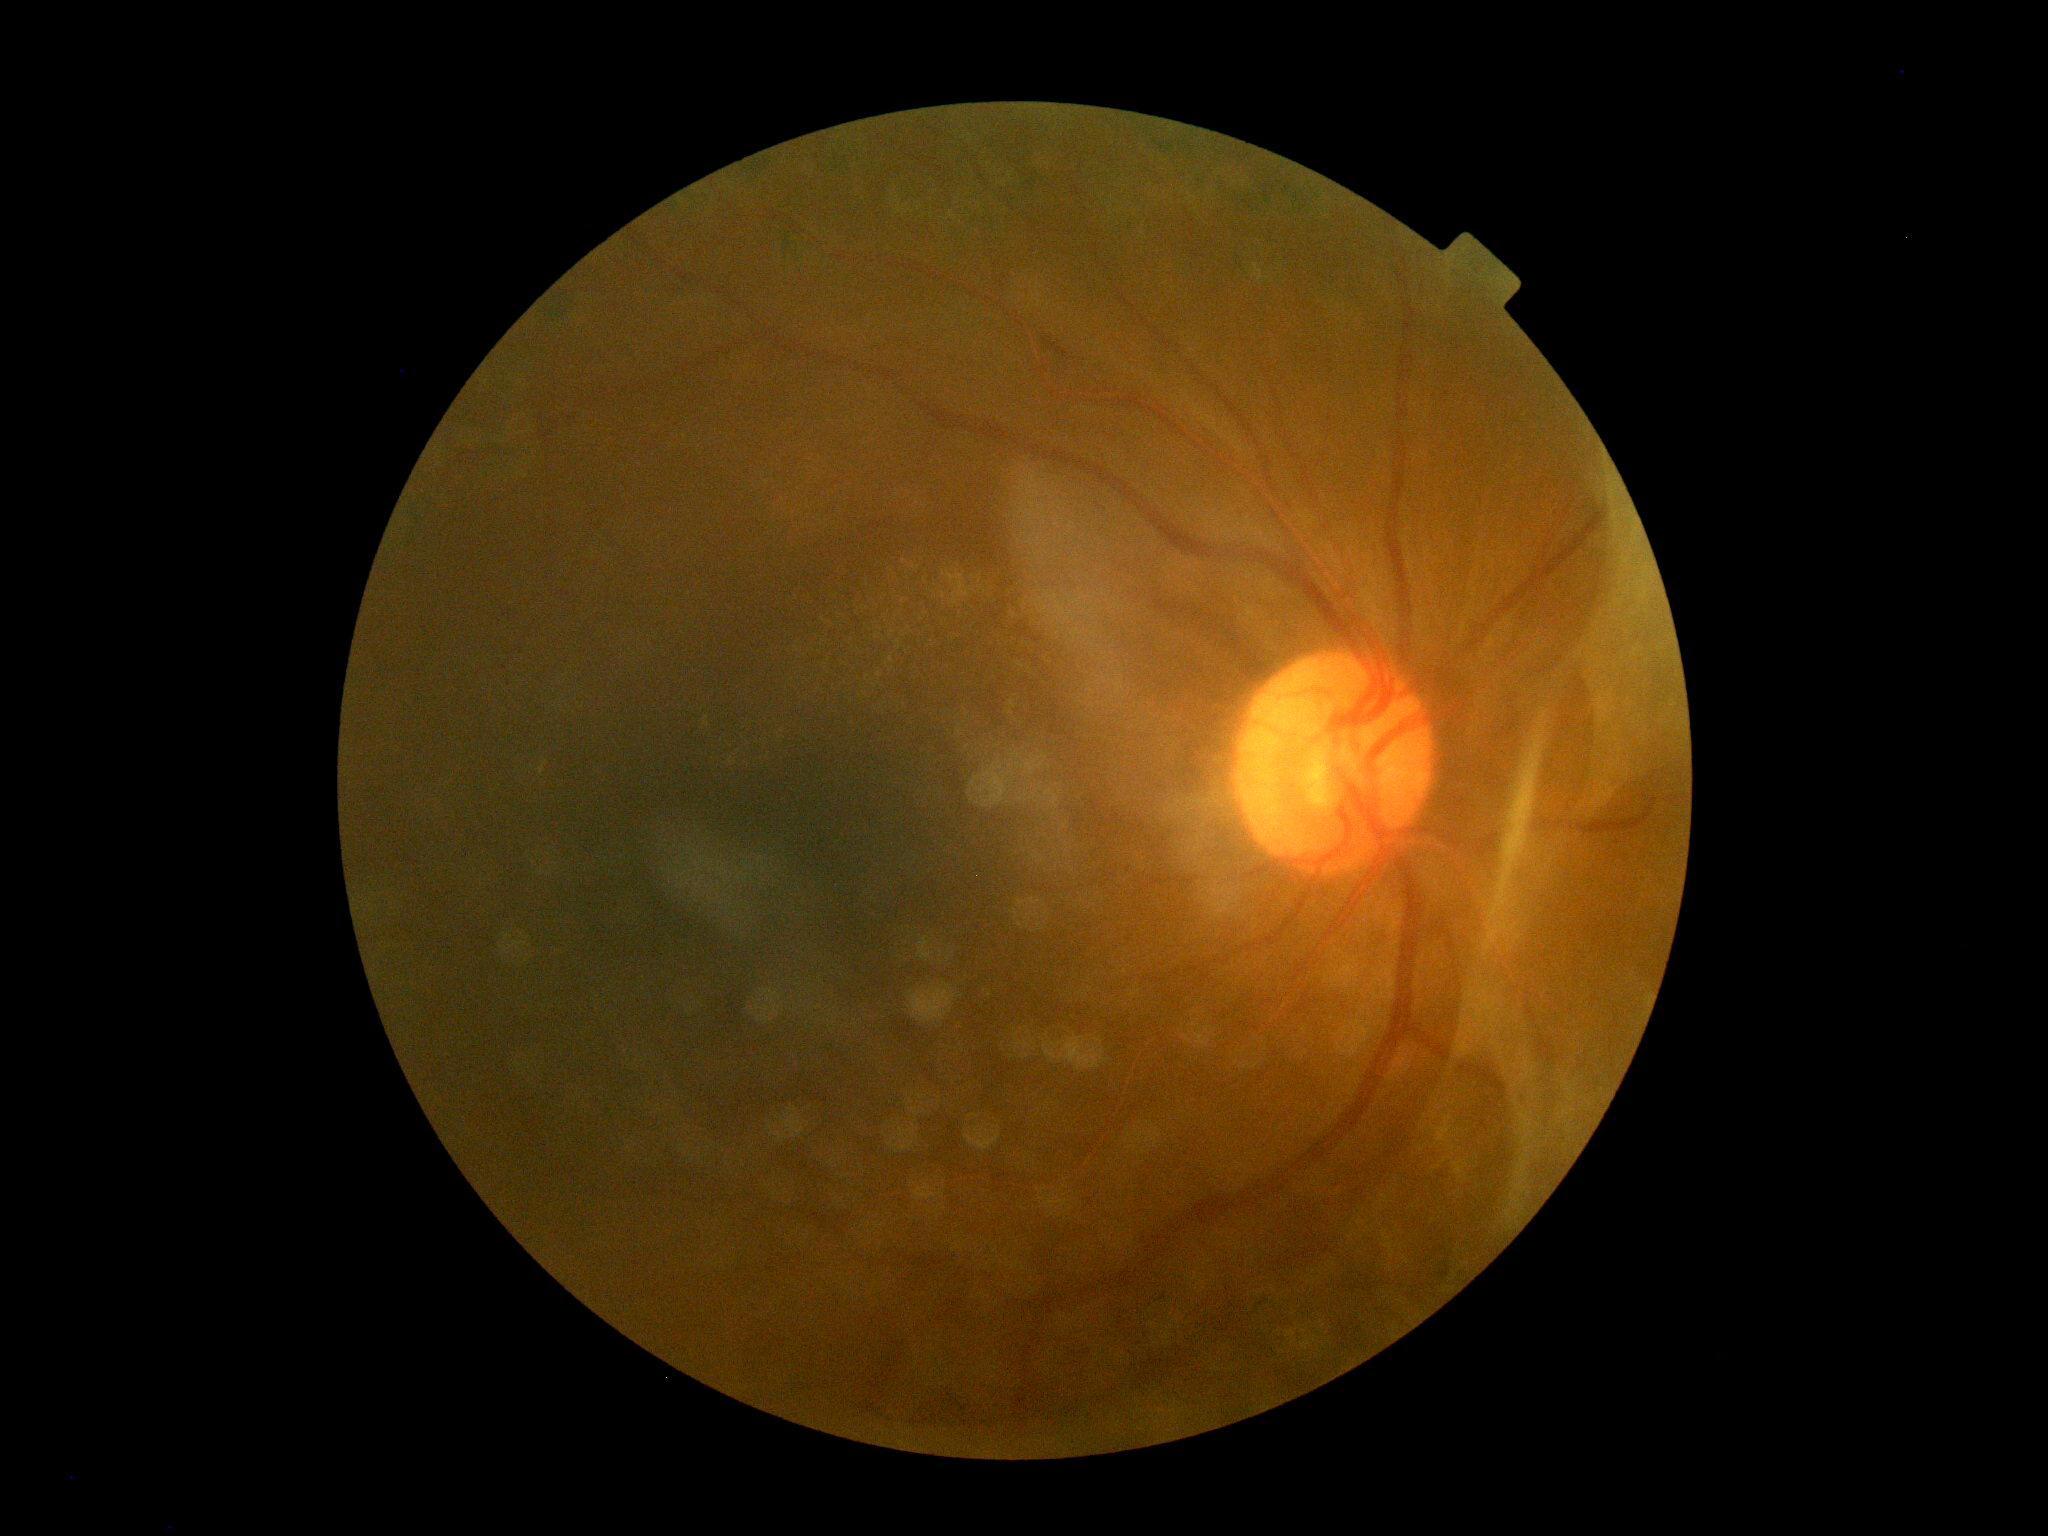

Diabetic retinopathy grade: 4/4.